1440x1080px. Captured with the Natus RetCam Envision (130° field of view). Pediatric retinal photograph (wide-field): 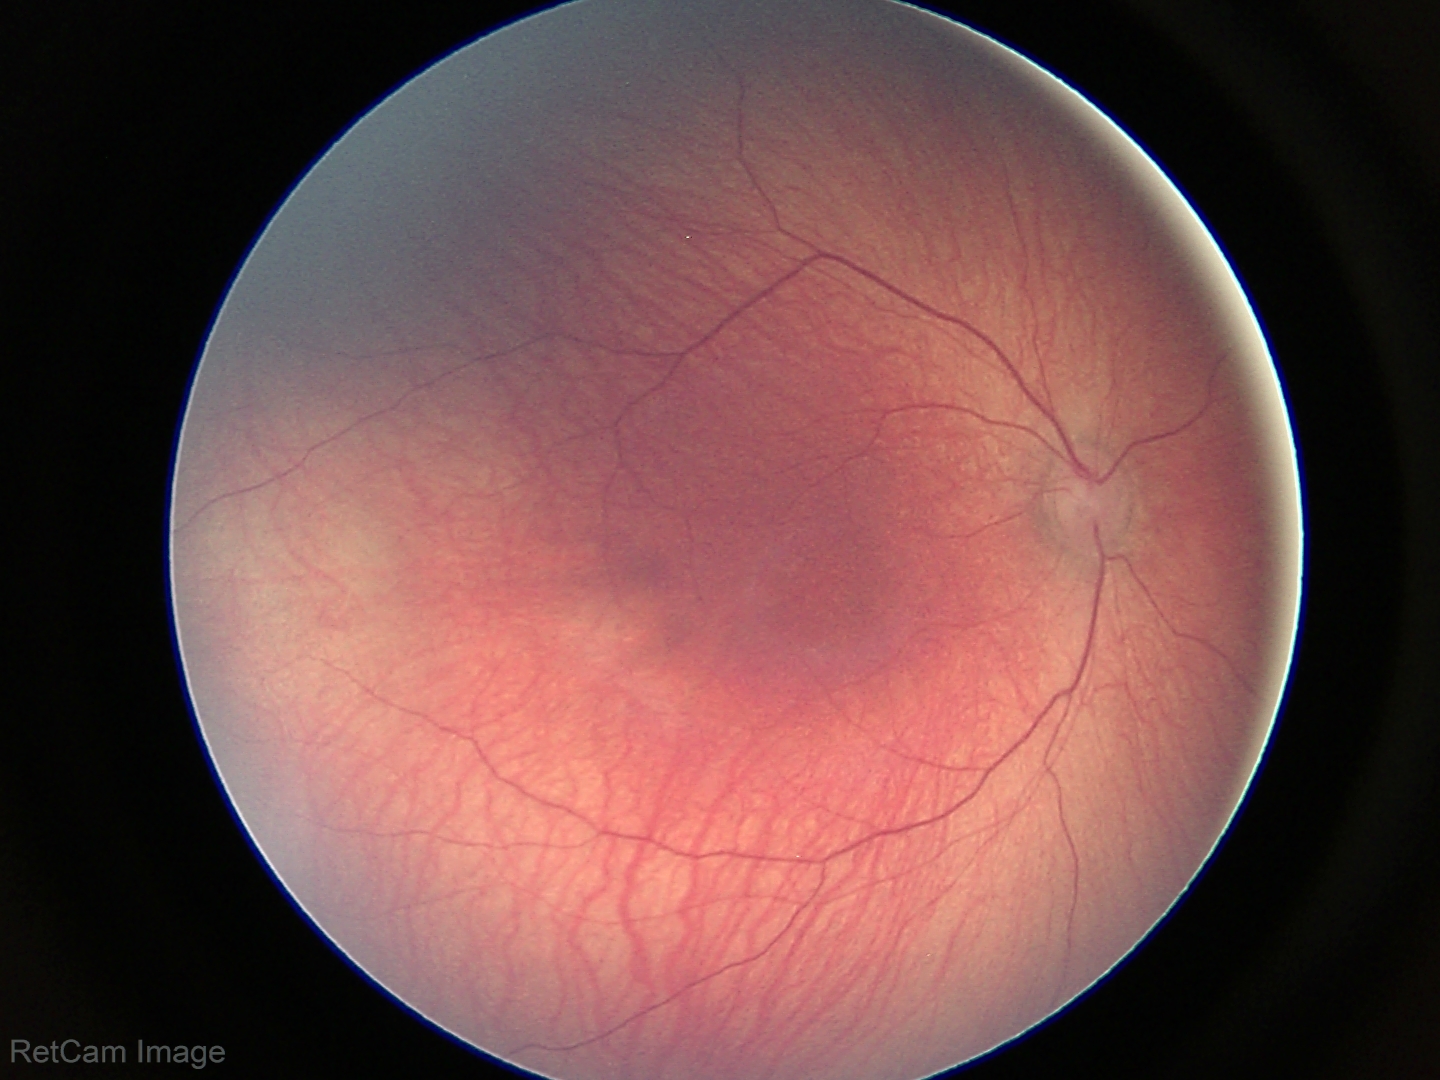 Screening examination diagnosed as physiological.